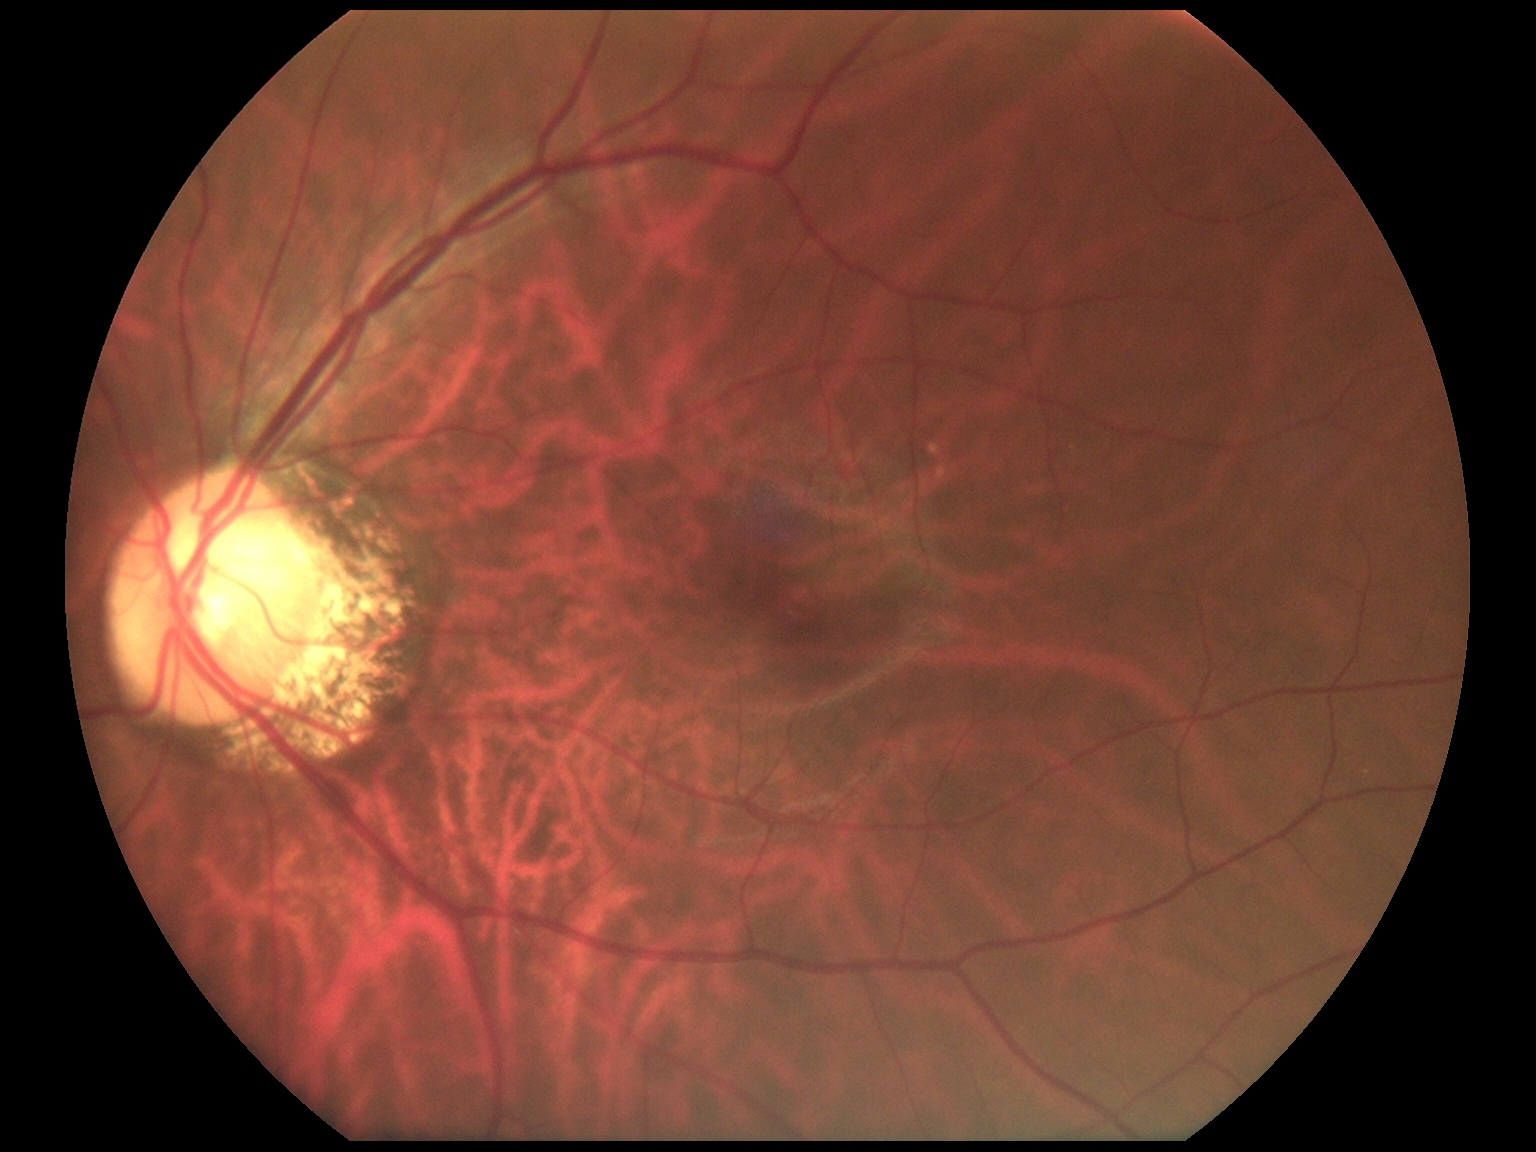 retinopathy = no apparent diabetic retinopathy (grade 0).